Retinal fundus photograph.
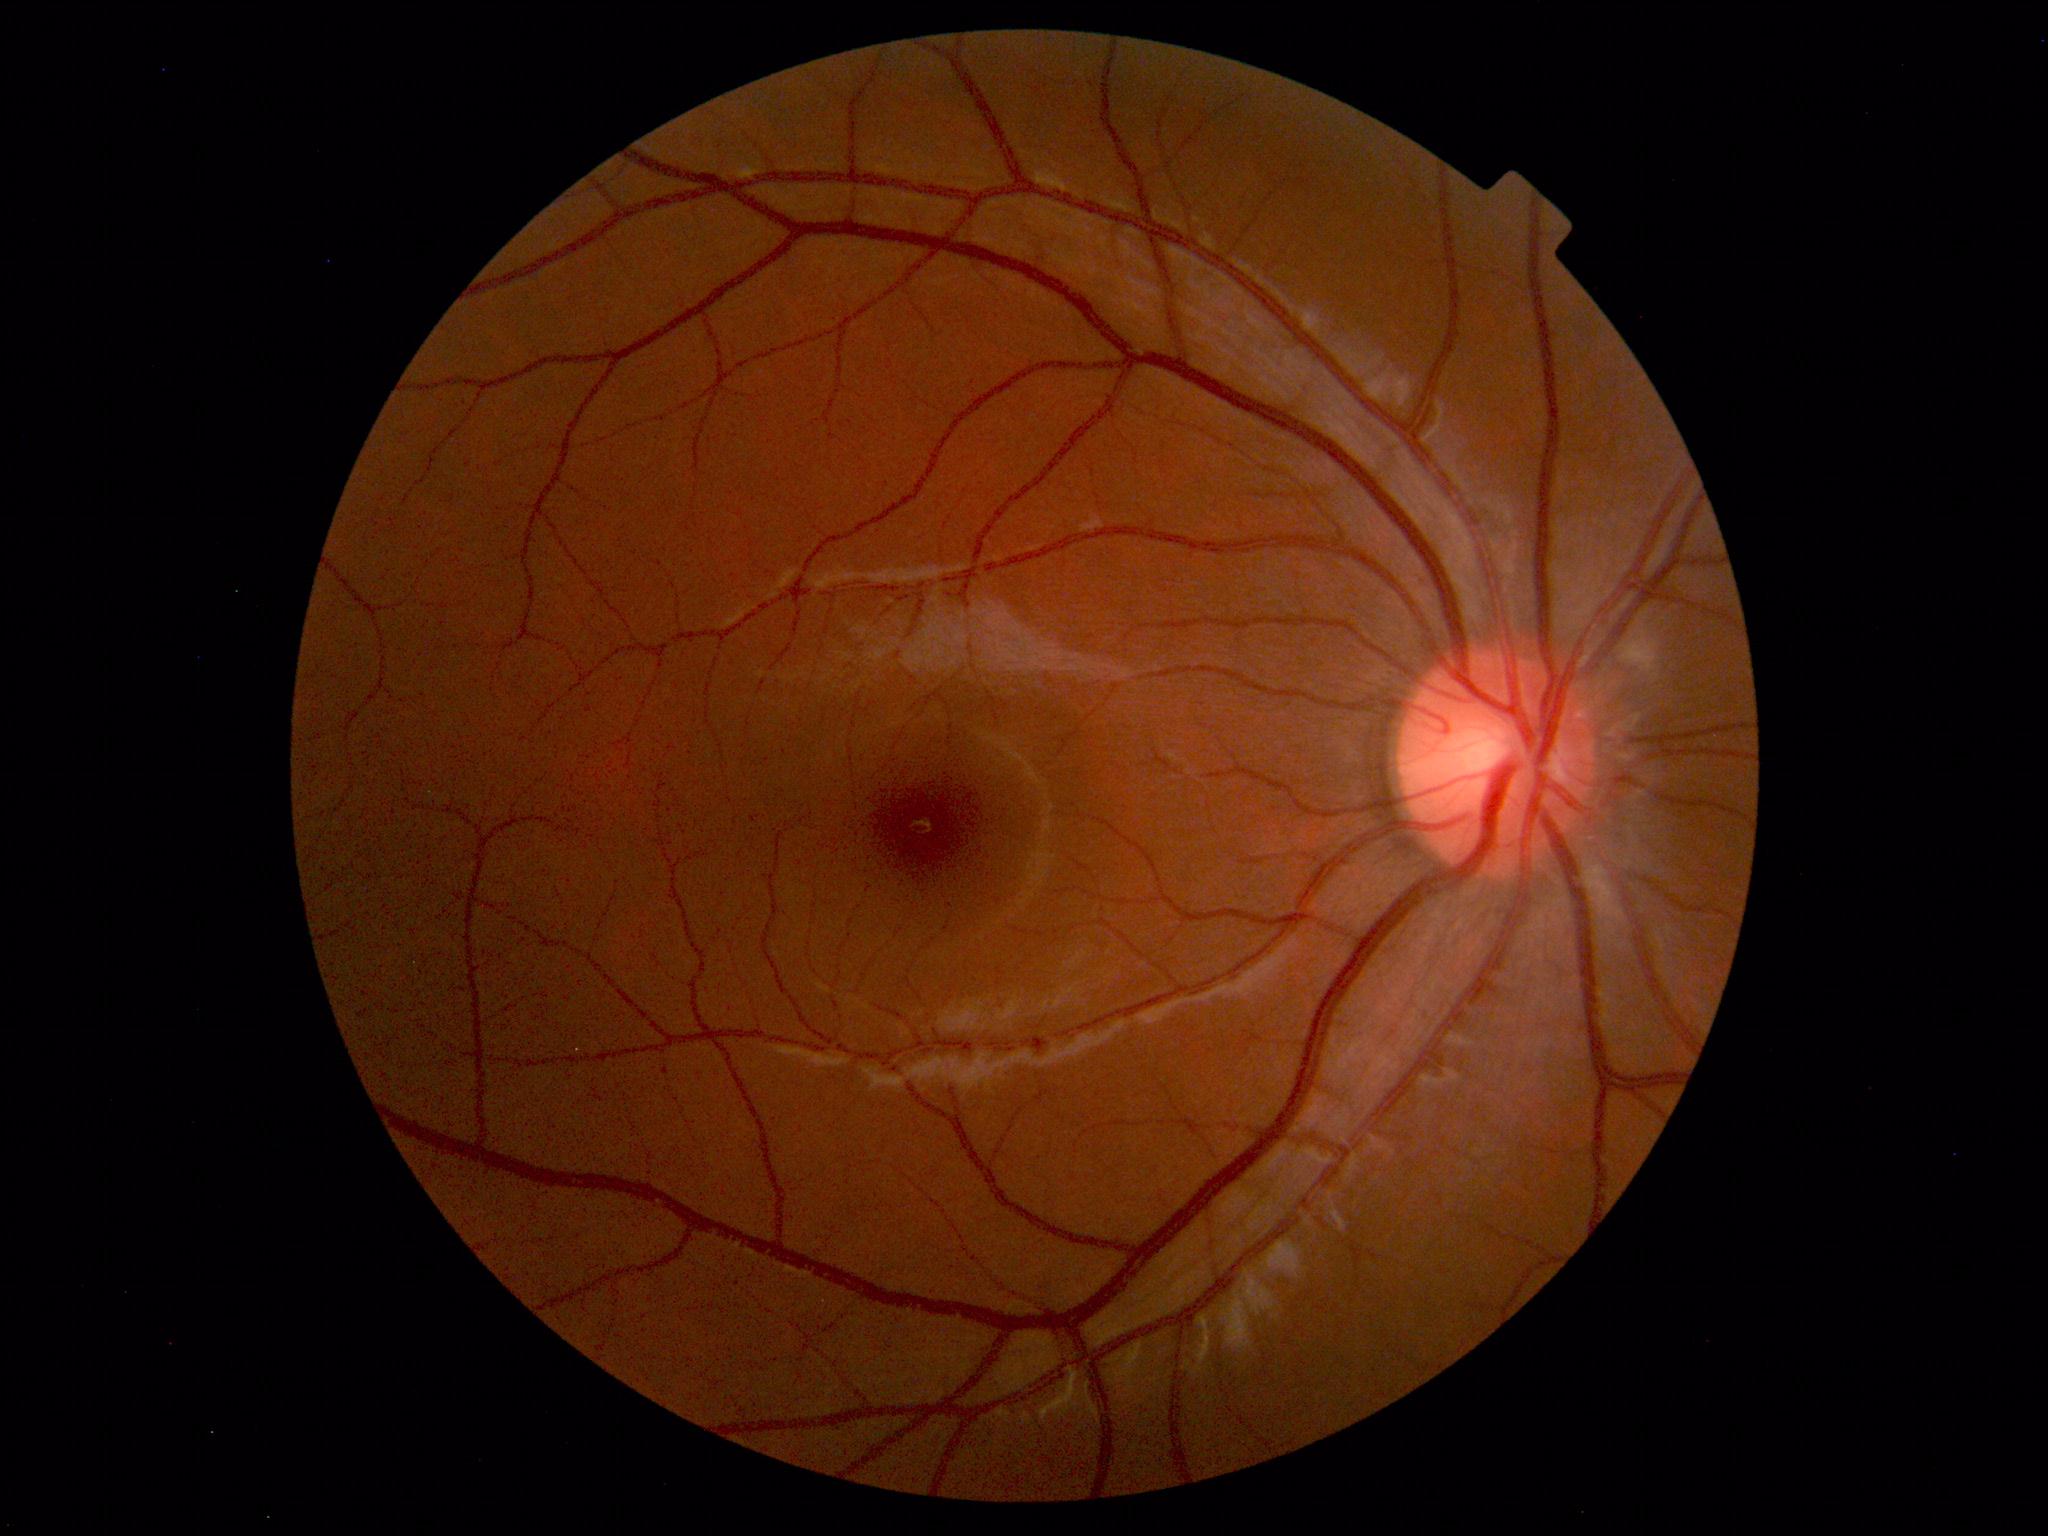
Impression: normal fundus.